Retinal fundus photograph. 45° FOV. 2352 x 1568 pixels
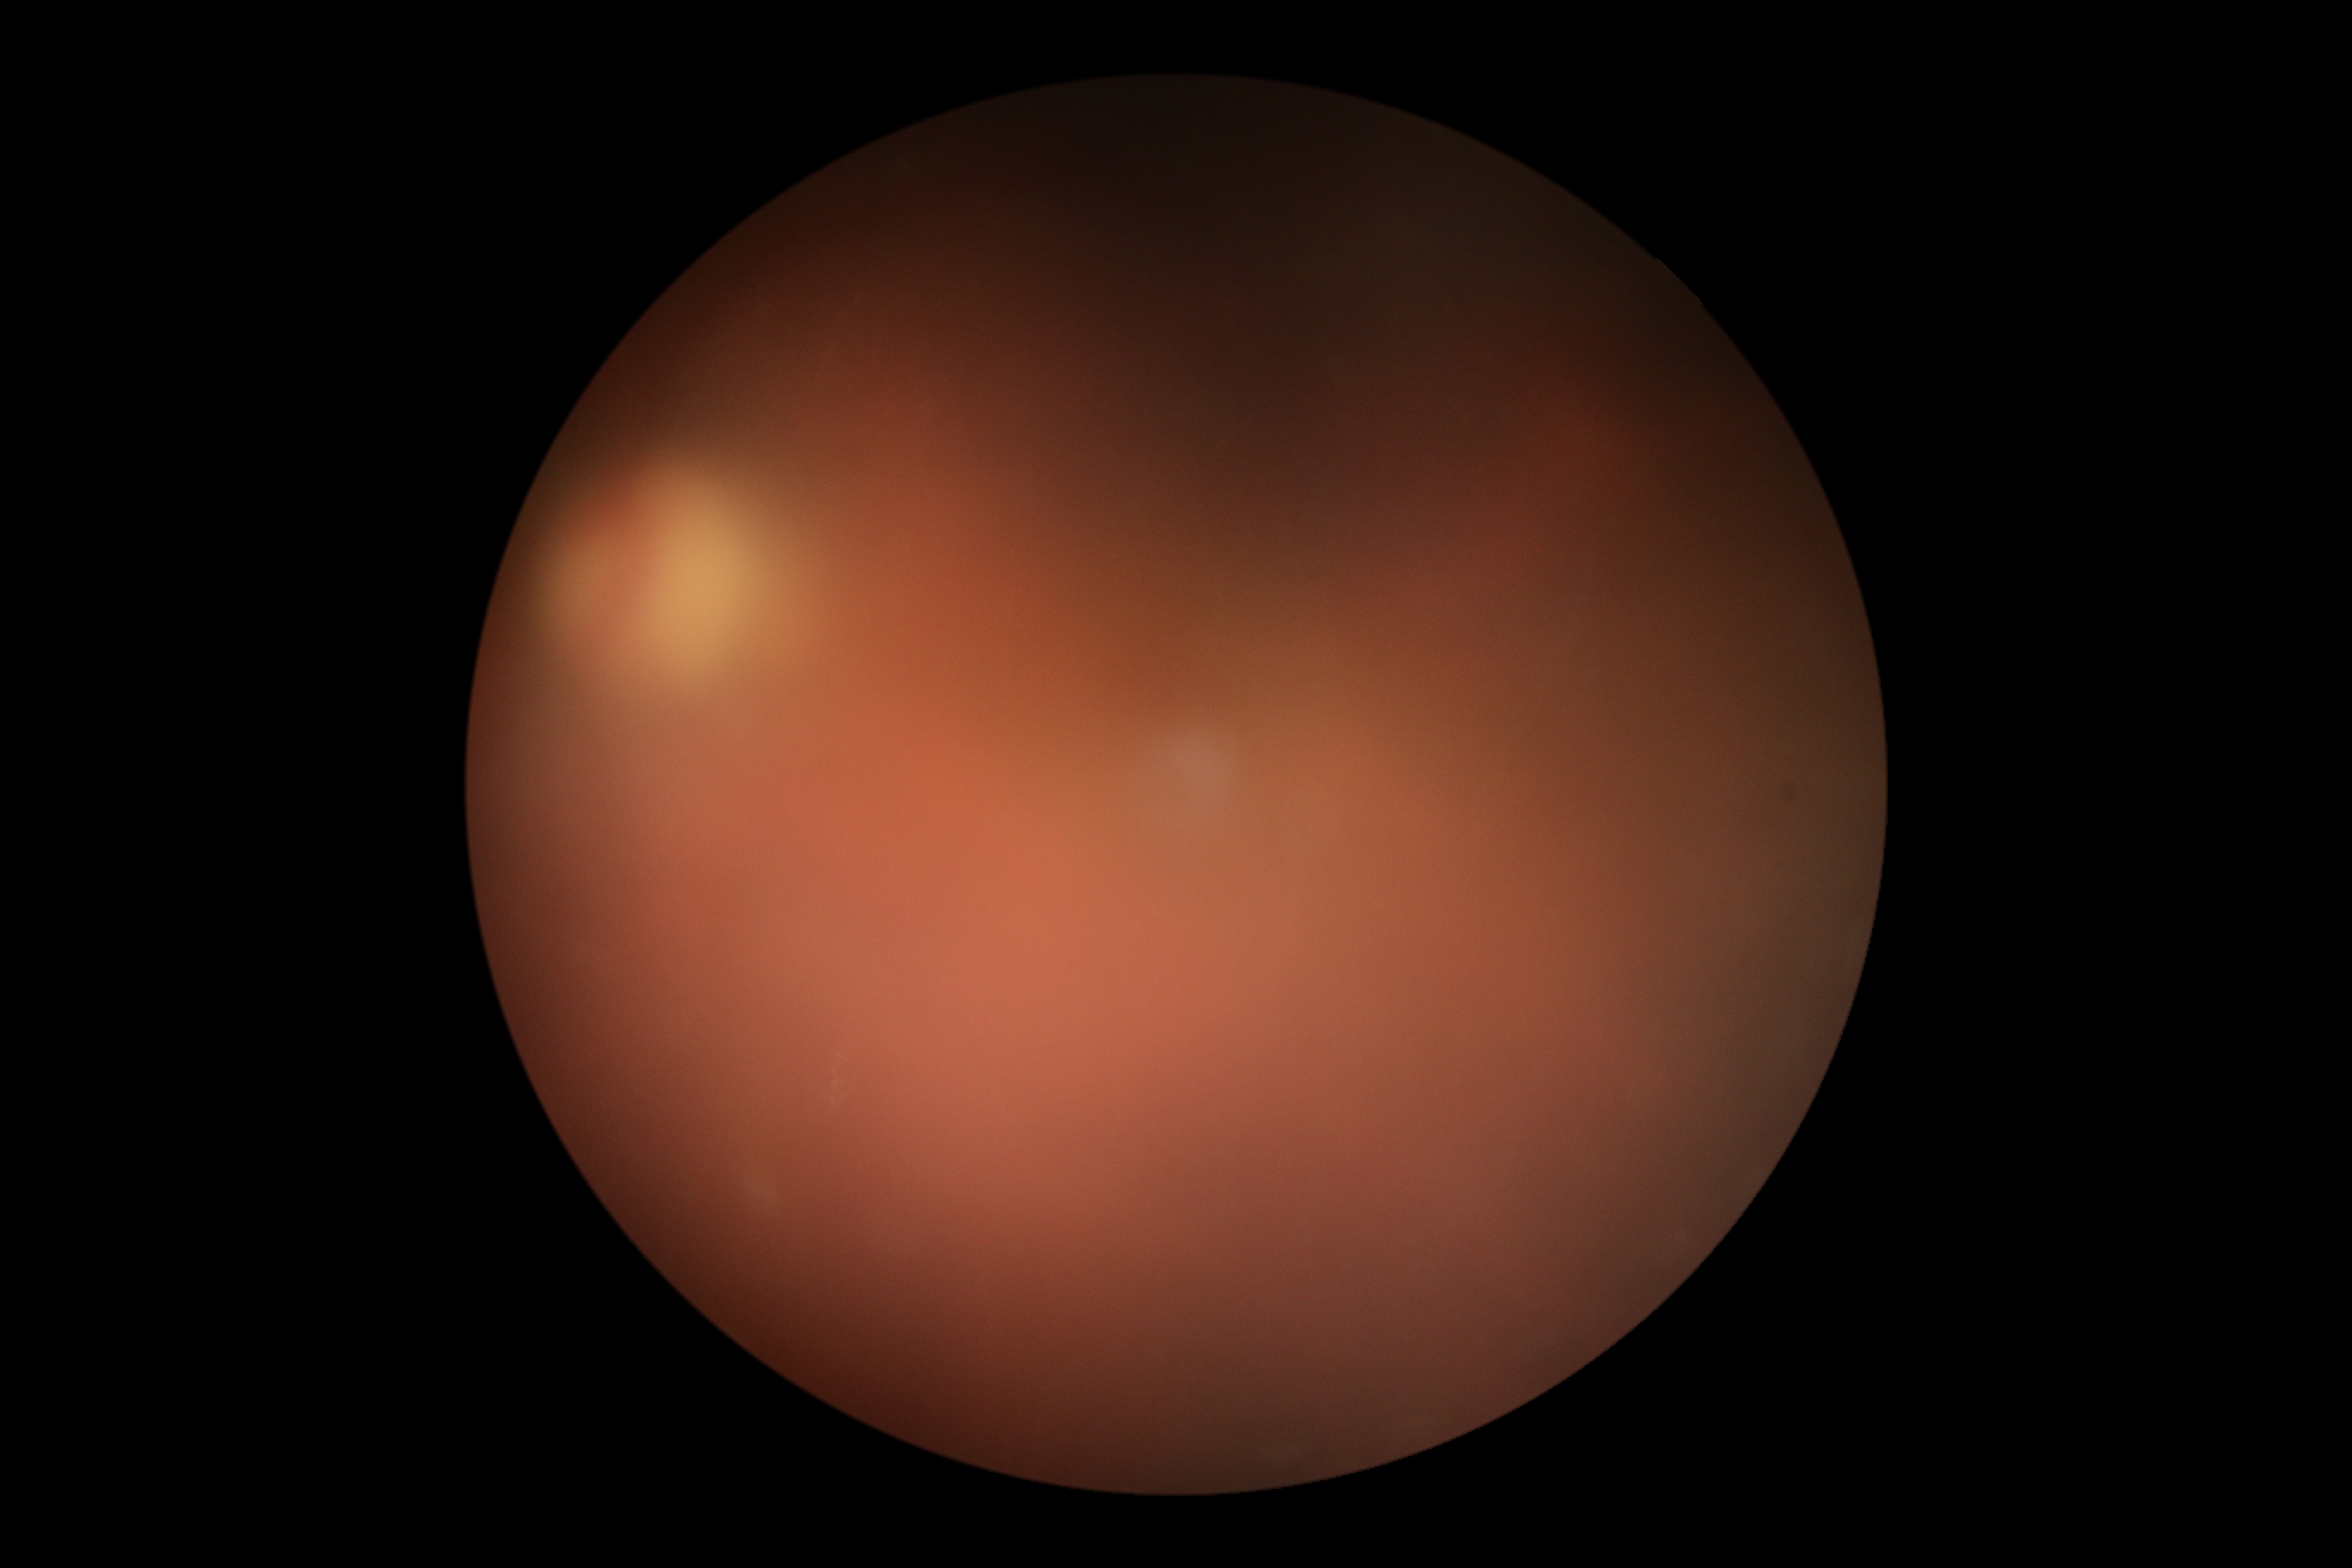 DR: ungradable due to poor image quality. Image quality is insufficient for diabetic retinopathy assessment.